45° field of view · 848x848px · diabetic retinopathy graded by the modified Davis classification — 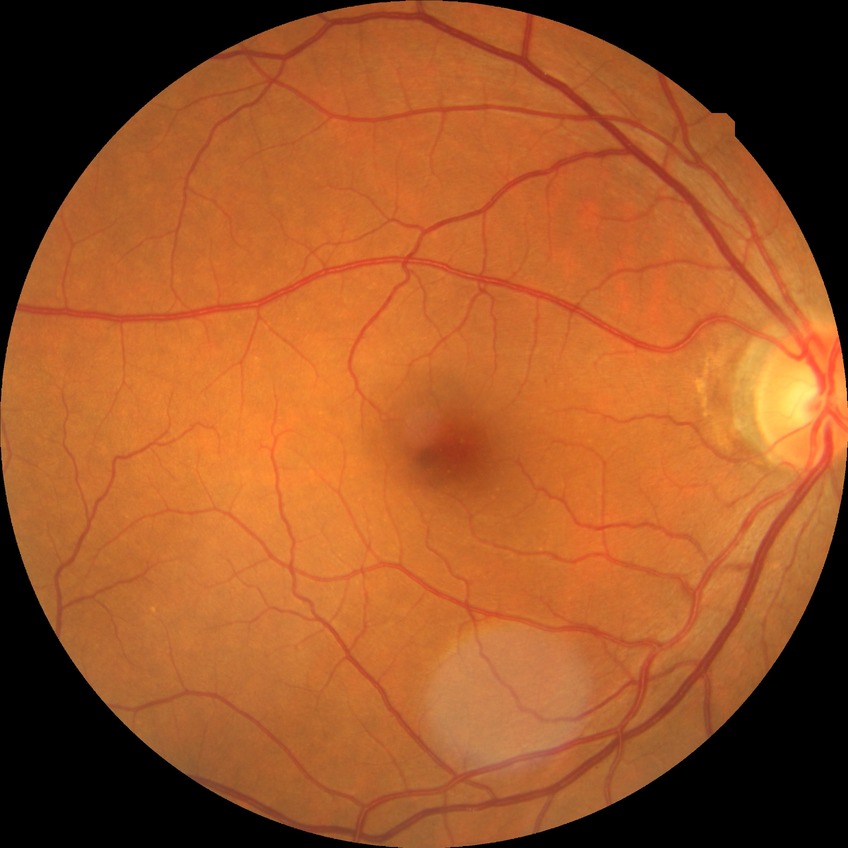

DR severity = NDR.